2212x1659, fundus photo, 45° FOV:
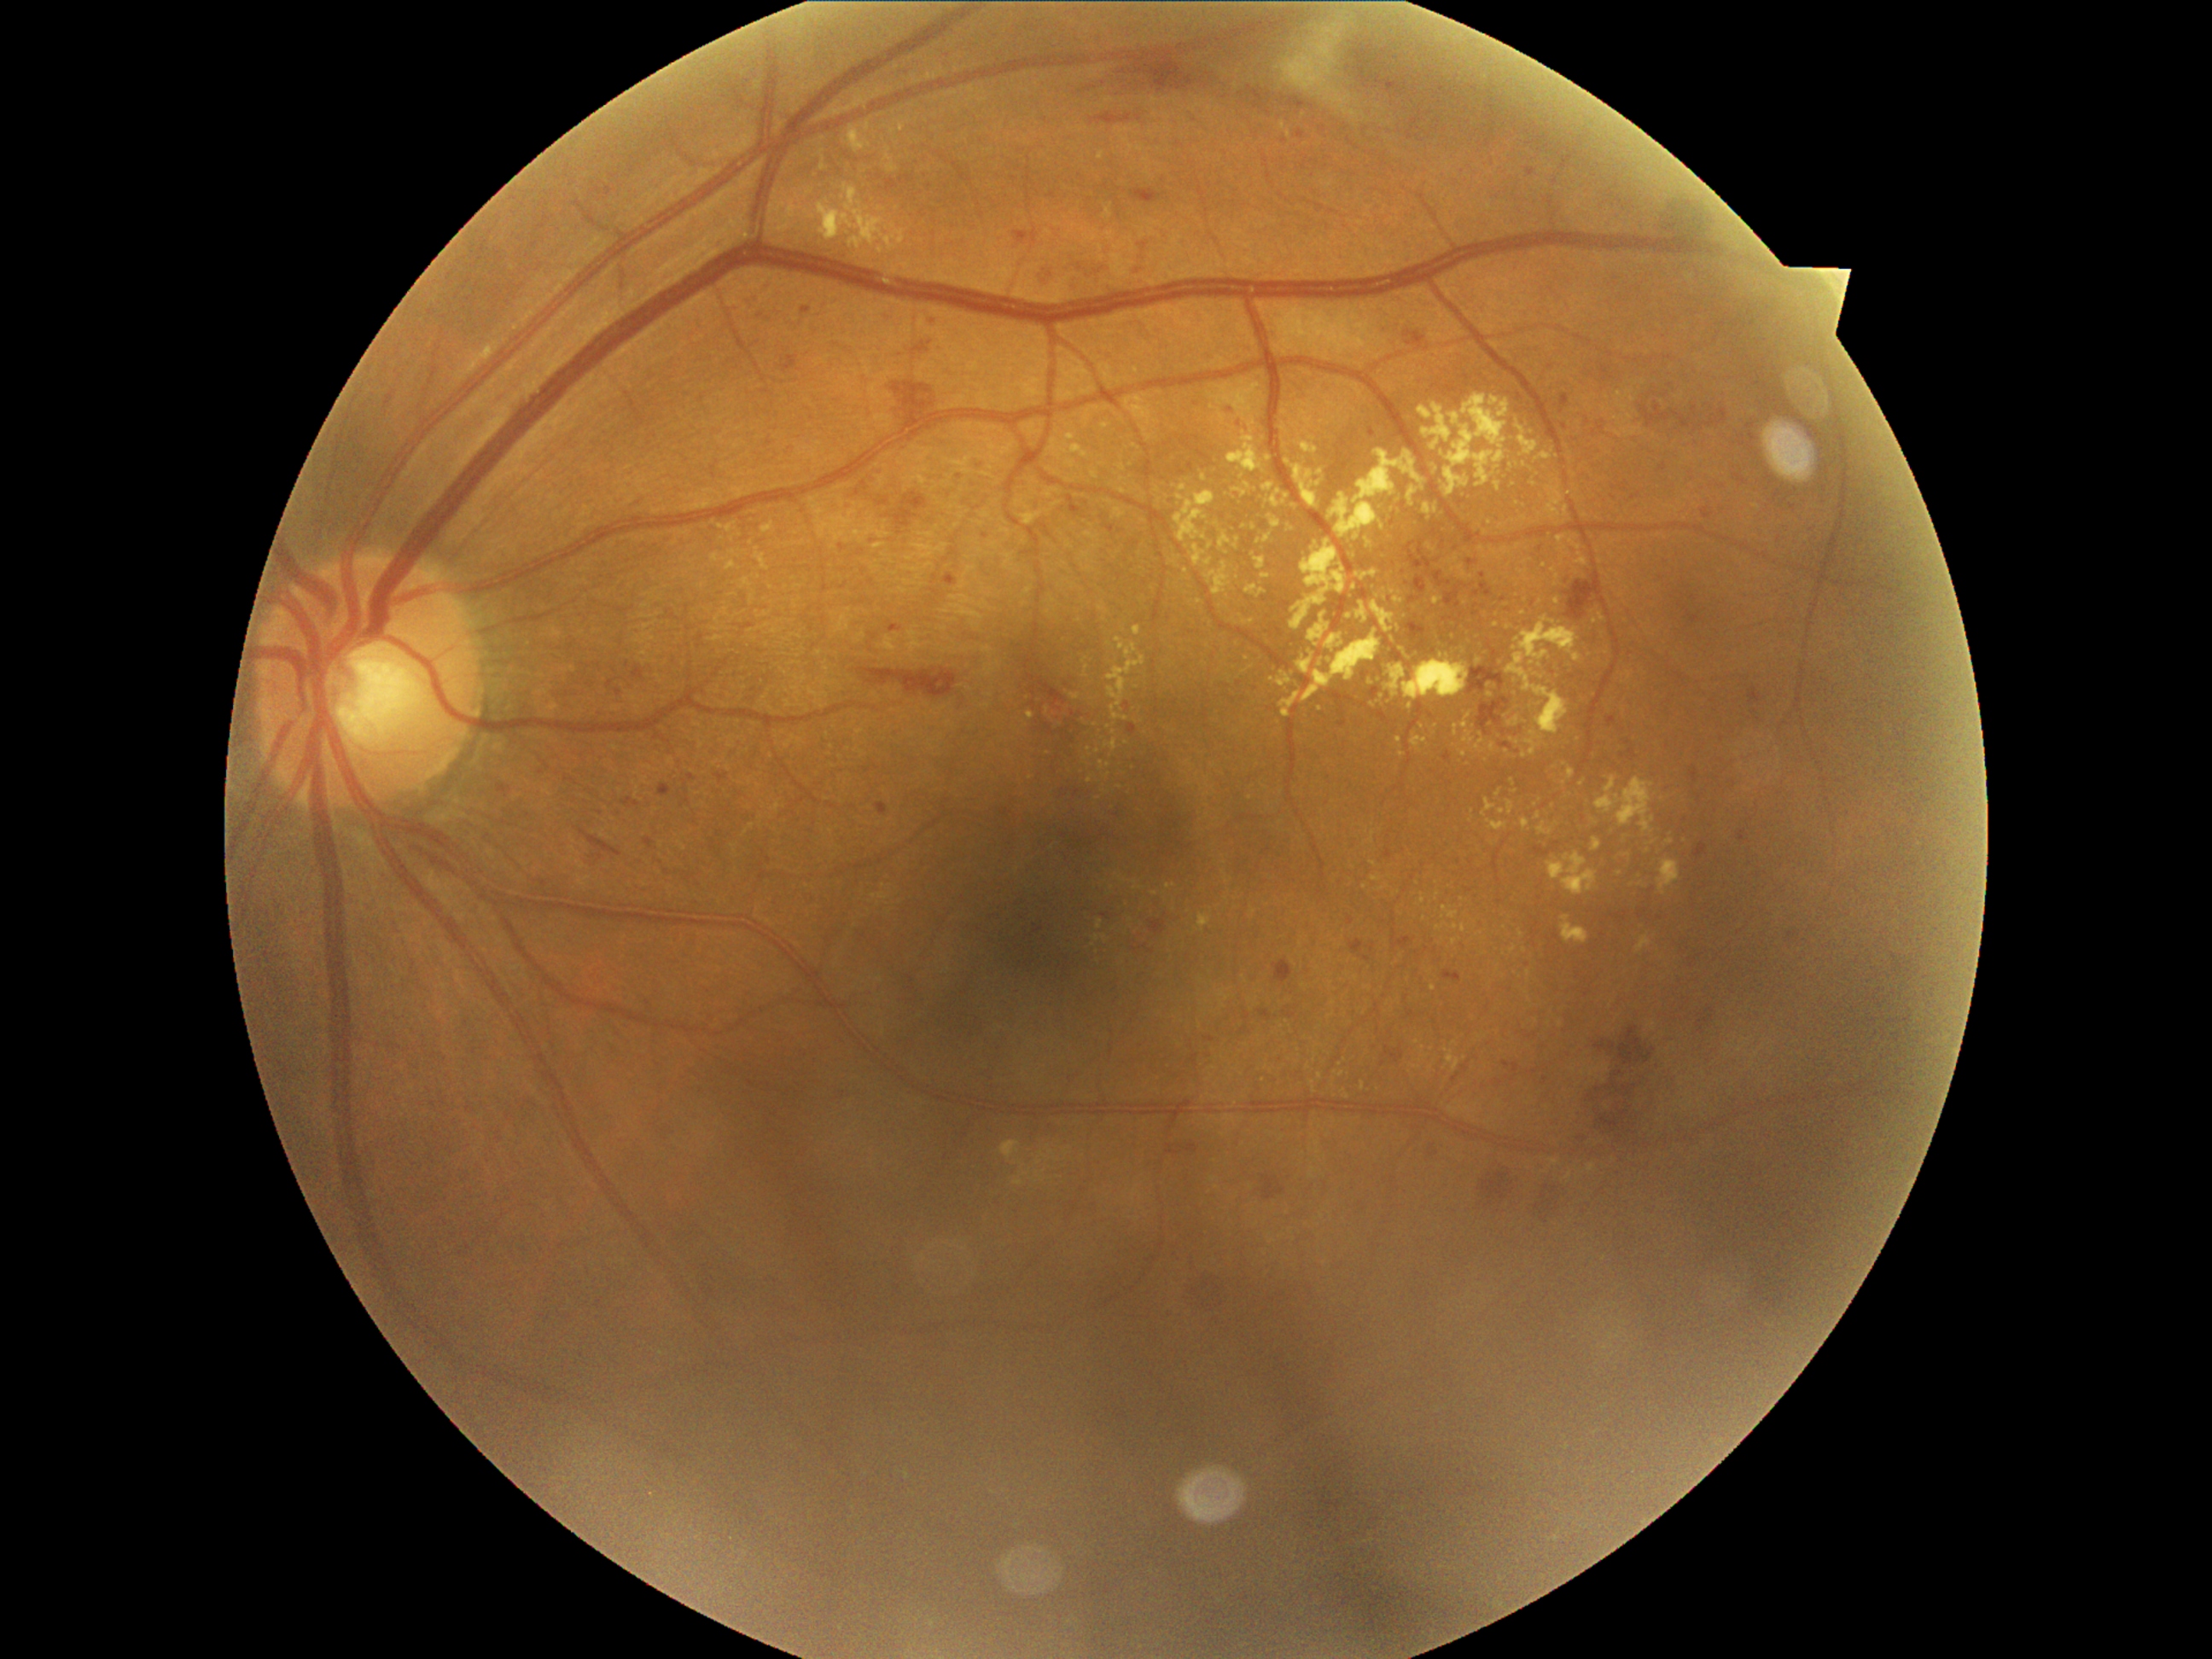
DR stage is moderate non-proliferative diabetic retinopathy (grade 2). EXs (partial list) at BBox(1027, 711, 1035, 719); BBox(759, 521, 776, 533); BBox(1001, 1141, 1022, 1161); BBox(1329, 450, 1426, 540); BBox(1462, 924, 1467, 934); BBox(1482, 800, 1496, 818); BBox(1431, 462, 1440, 475); BBox(1516, 421, 1539, 458); BBox(1334, 1071, 1346, 1076); BBox(1134, 627, 1143, 637). Small EXs approximately at pt(1095, 939); pt(1621, 873); pt(1089, 750); pt(1318, 970); pt(1433, 725); pt(1491, 686); pt(1334, 1003); pt(1509, 628); pt(1781, 760); pt(1186, 571). MAs (partial list) at BBox(1694, 844, 1708, 861); BBox(868, 579, 875, 588); BBox(1127, 723, 1138, 735); BBox(870, 538, 878, 550); BBox(888, 624, 904, 634); BBox(757, 310, 771, 322); BBox(499, 783, 509, 796); BBox(1697, 1015, 1714, 1035); BBox(1658, 465, 1668, 472); BBox(1501, 743, 1513, 750); BBox(1578, 1136, 1586, 1143); BBox(974, 462, 982, 475); BBox(1749, 687, 1764, 704); BBox(1738, 830, 1747, 842). Small MAs approximately at pt(1540, 549); pt(1503, 732); pt(1587, 422); pt(1323, 130). HEs (partial list) at BBox(894, 509, 917, 528); BBox(1672, 410, 1692, 429); BBox(1586, 1073, 1641, 1138); BBox(1619, 1027, 1656, 1066); BBox(890, 668, 958, 699); BBox(1289, 100, 1308, 110); BBox(1068, 496, 1081, 516); BBox(1040, 260, 1049, 286); BBox(1071, 257, 1110, 277); BBox(1132, 189, 1163, 204); BBox(1477, 697, 1511, 735); BBox(1447, 583, 1467, 607); BBox(1240, 86, 1272, 117); BBox(1701, 409, 1728, 429); BBox(1259, 1010, 1276, 1022); BBox(1409, 598, 1419, 605); BBox(1134, 233, 1151, 274); BBox(1103, 525, 1115, 535). Small HEs approximately at pt(1459, 606); pt(1477, 614).